Image size 1440x1080. Infant wide-field fundus photograph:
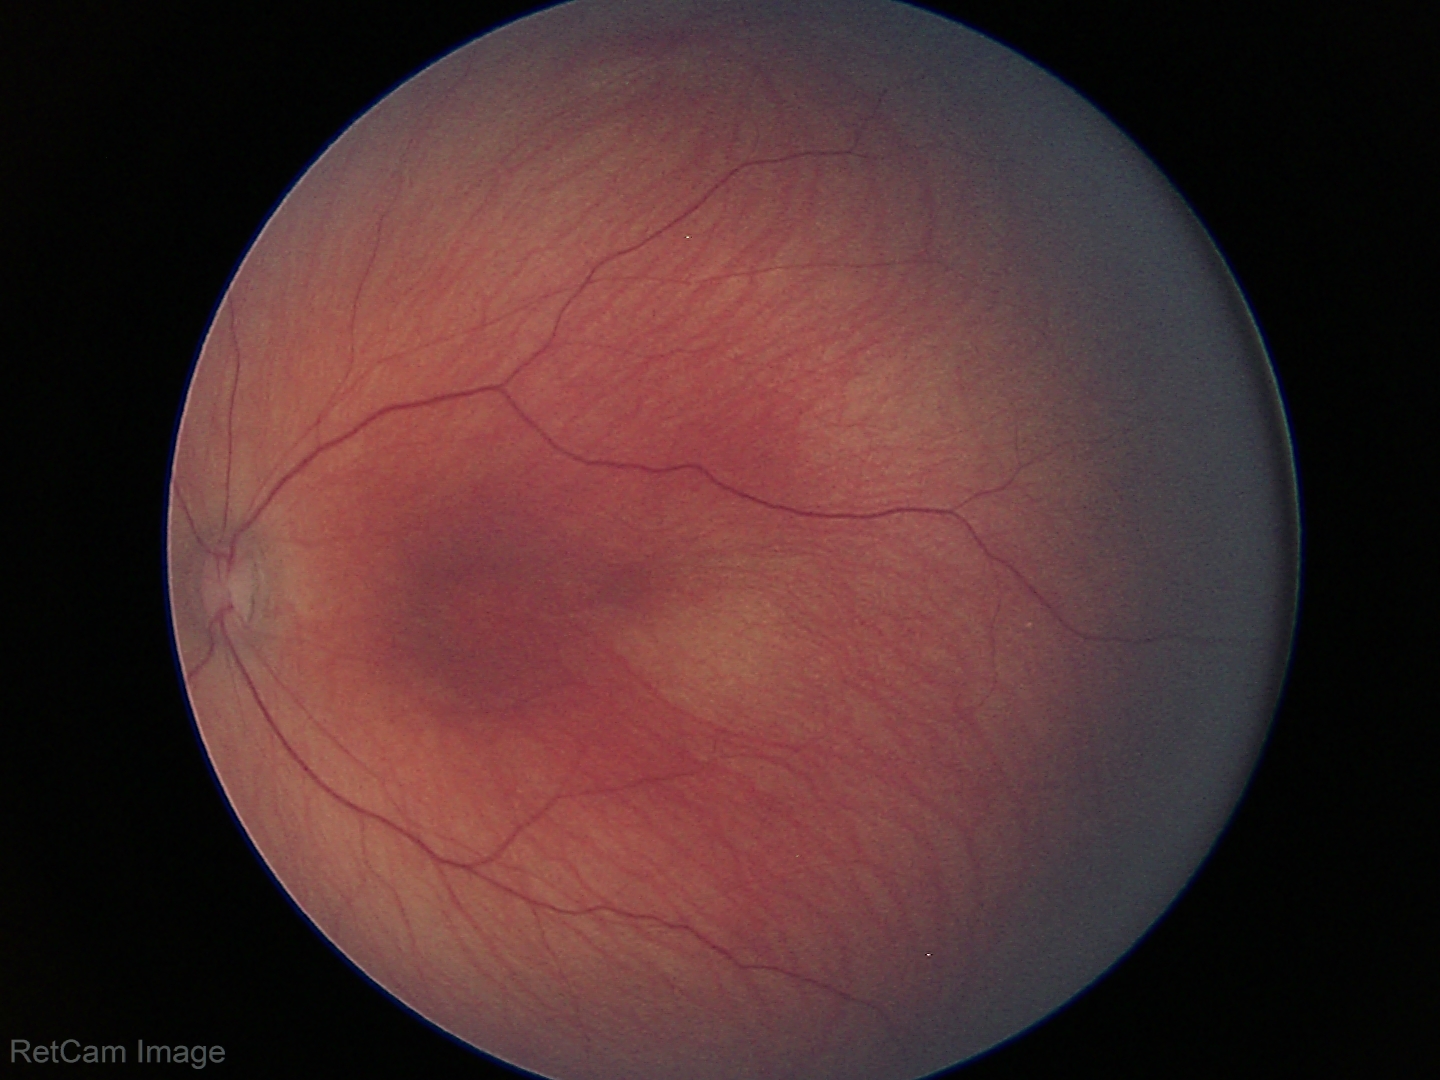 Diagnosis: physiological appearance.